FOV: 50 degrees
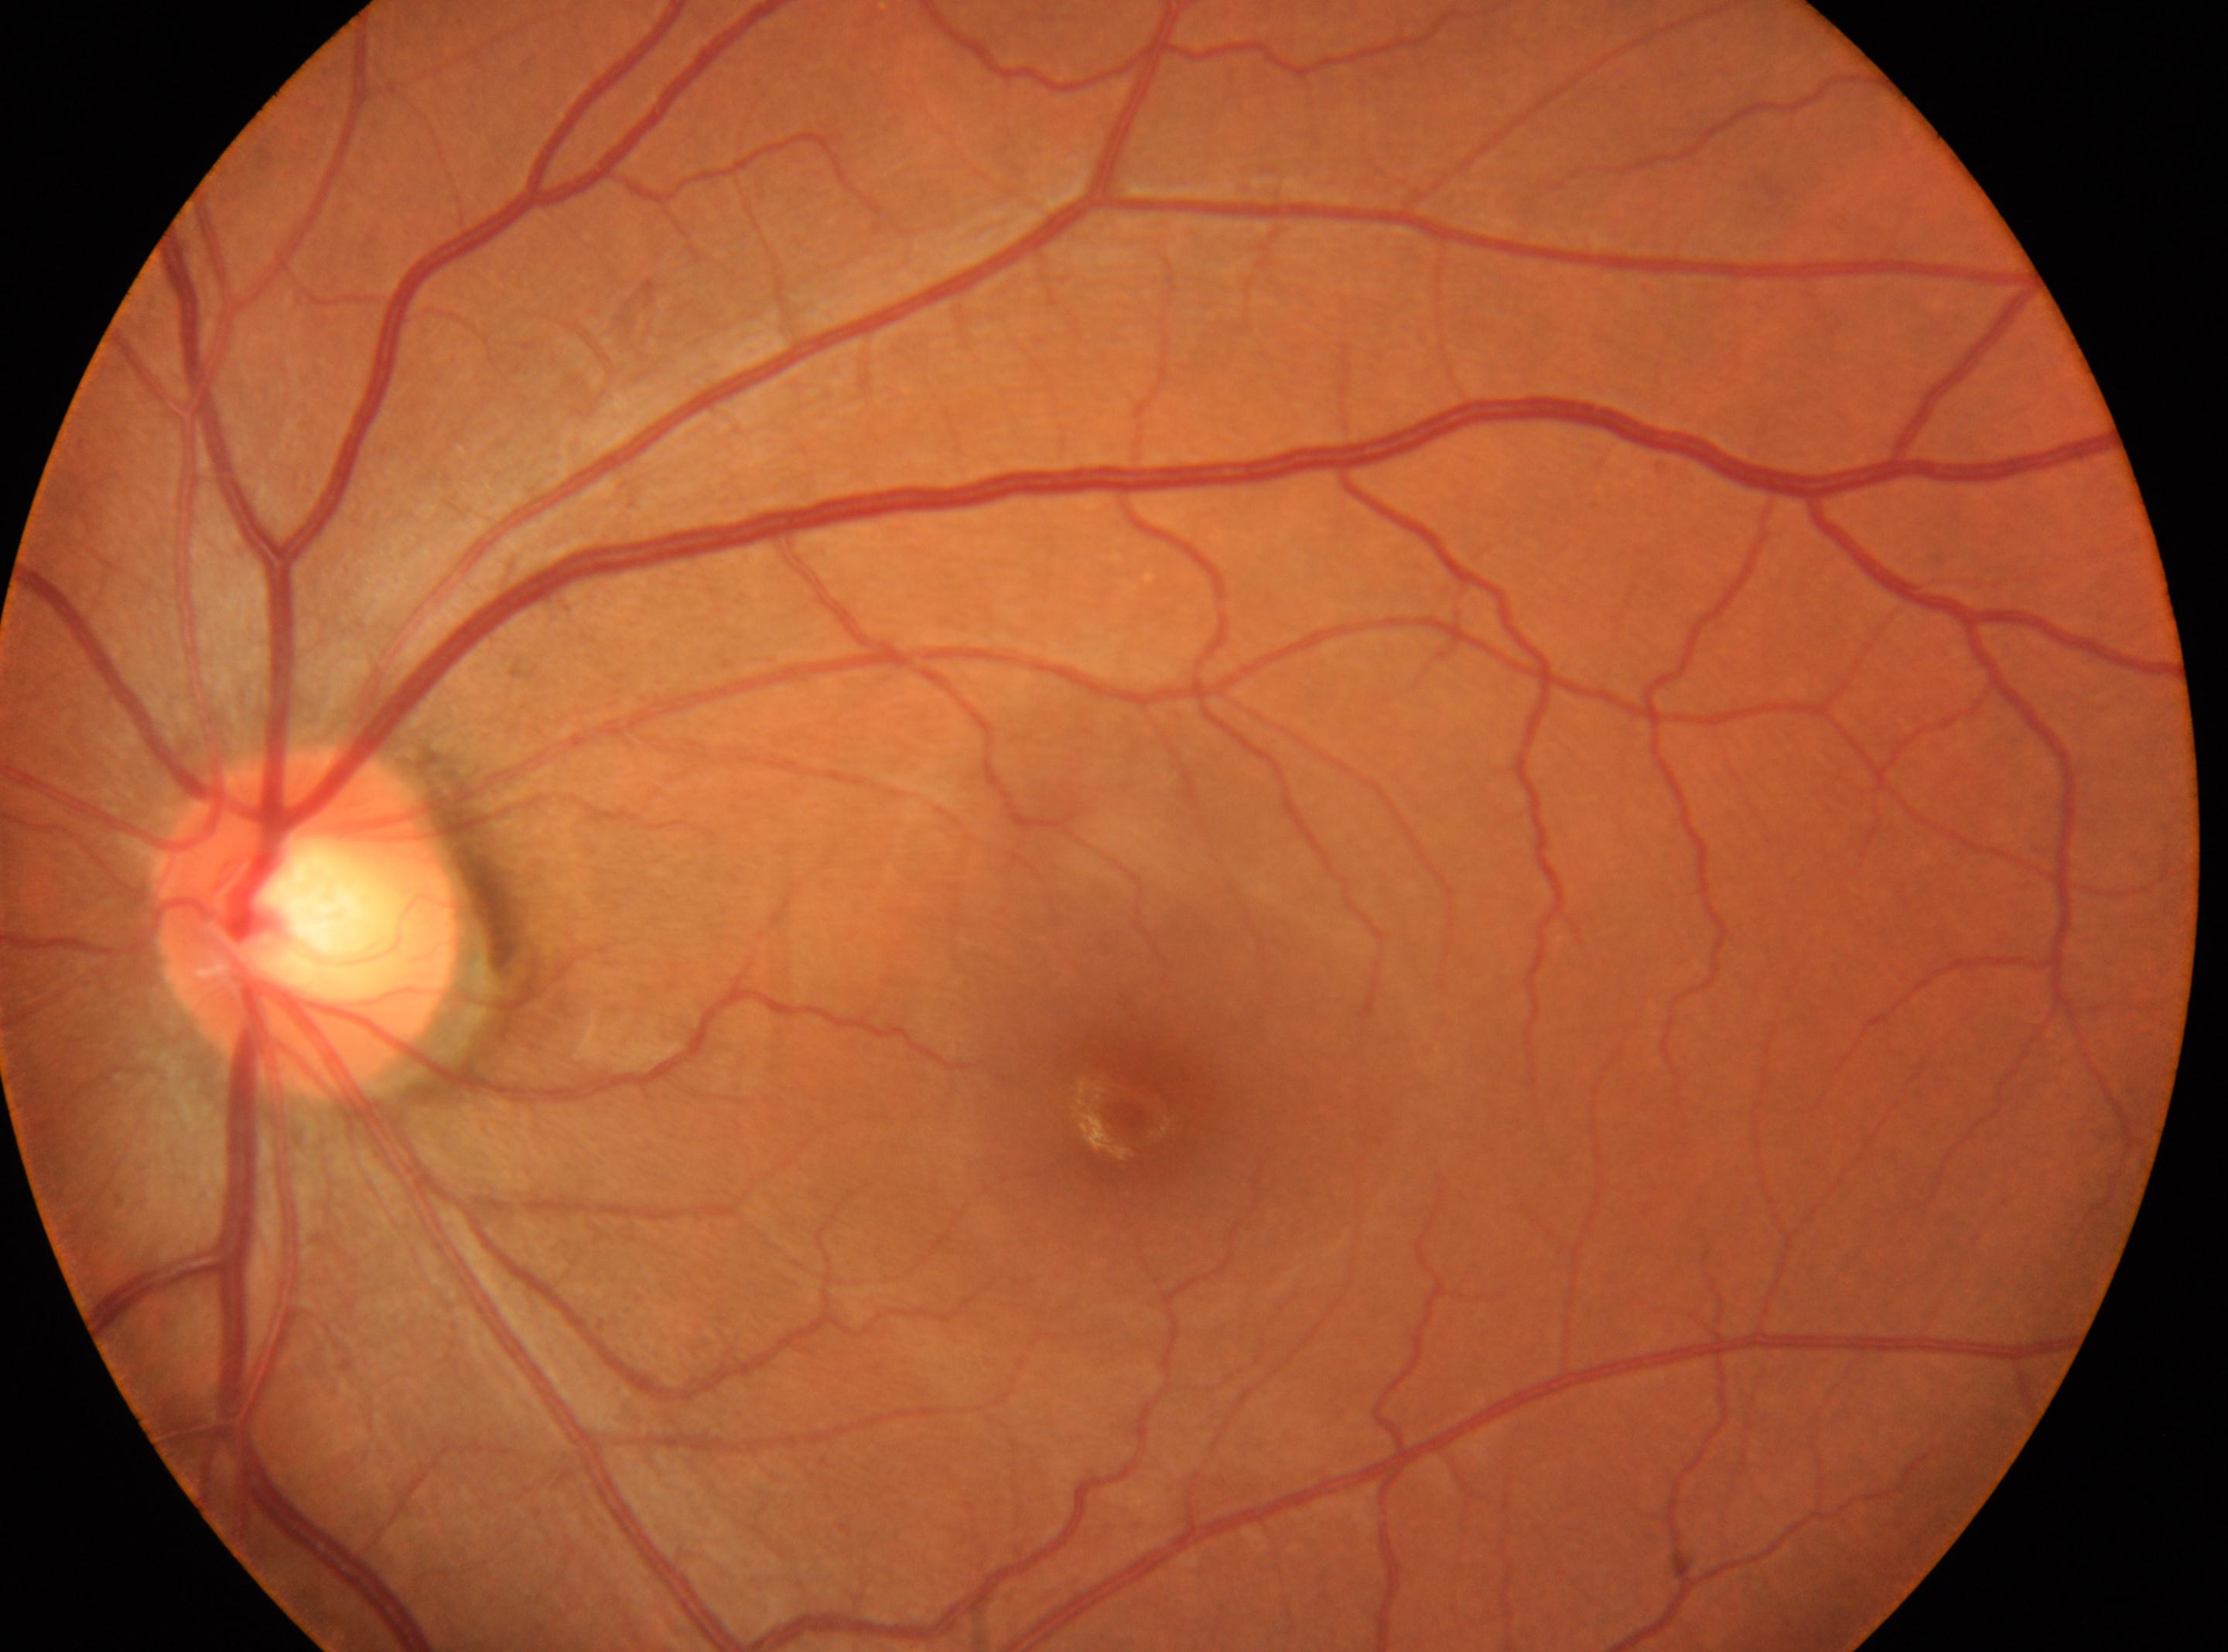
eye: OS | macula center: [1131, 1111] | diabetic retinopathy (DR): no apparent diabetic retinopathy (grade 0) | optic disc: [303, 917].